45° FOV. Color fundus image:
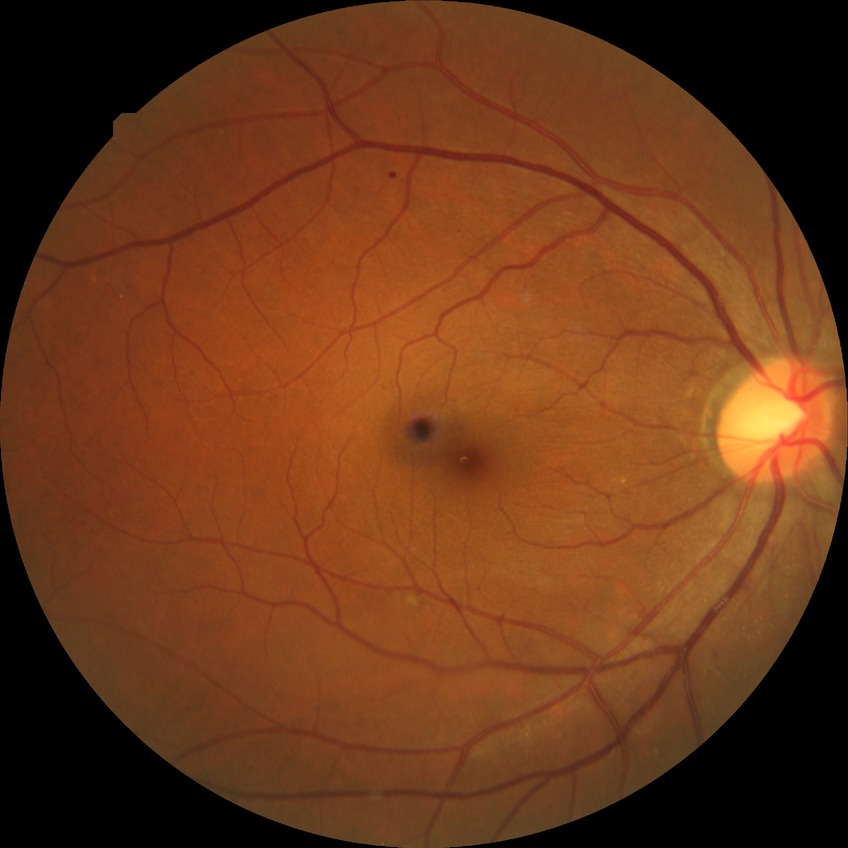
Retinopathy stage is pre-proliferative diabetic retinopathy.